Wide-field contact fundus photograph of an infant; image size 1240x1240: 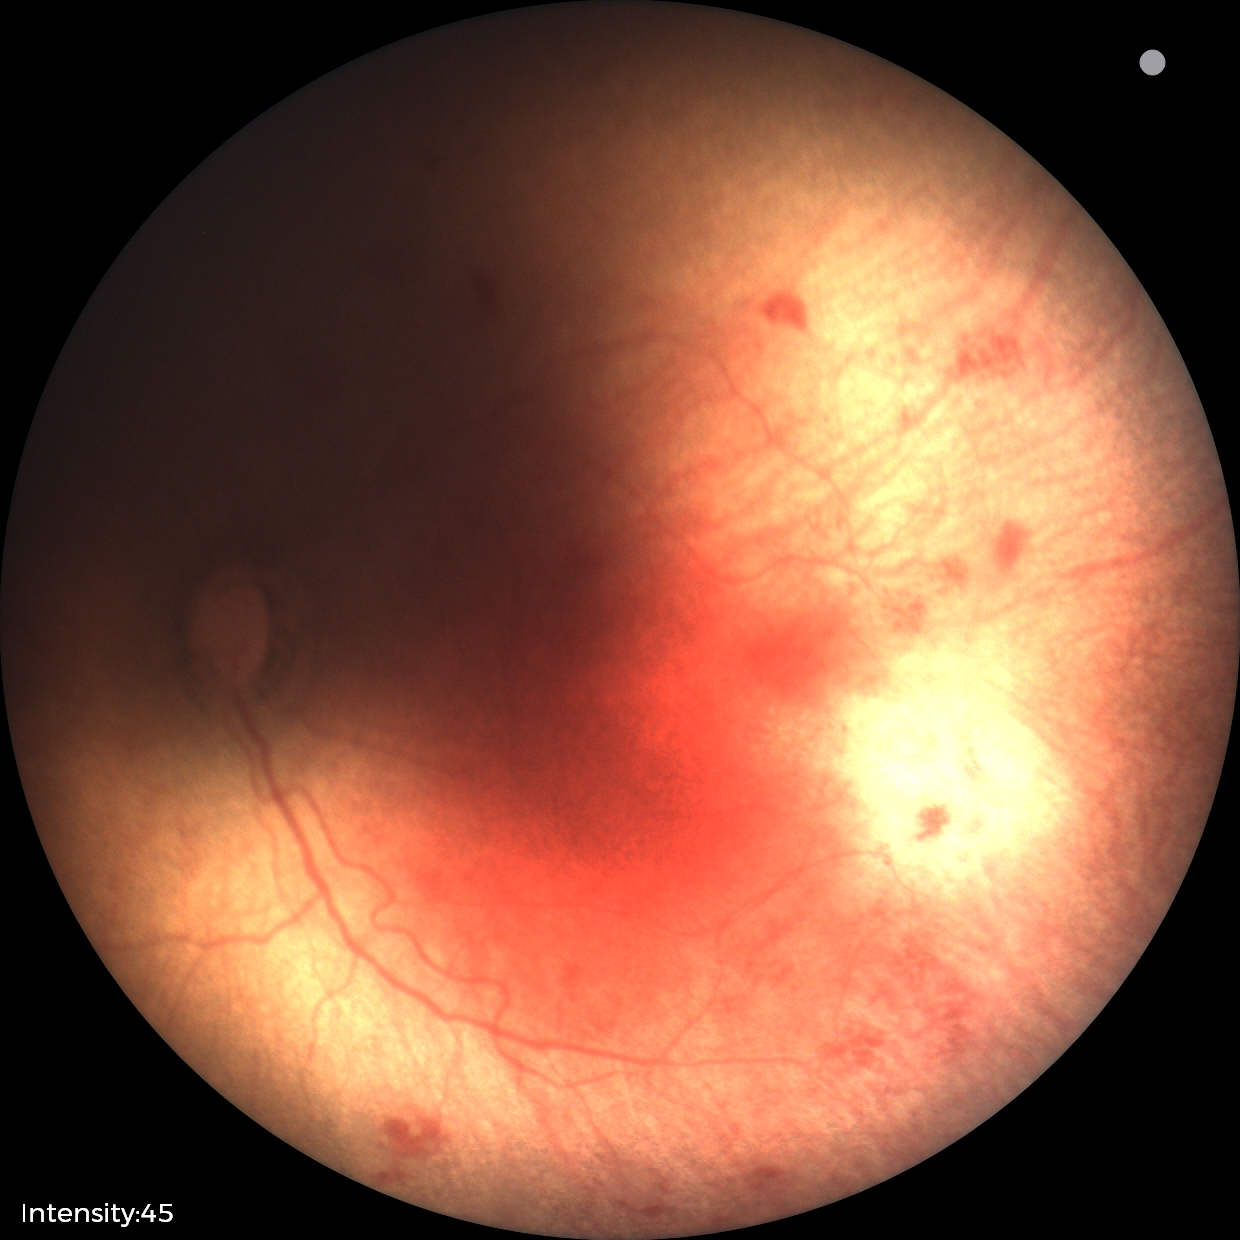
Screening diagnosis = retinopathy of prematurity stage 1 | plus disease = absent.